Retinal fundus photograph. 2048 by 1536 pixels.
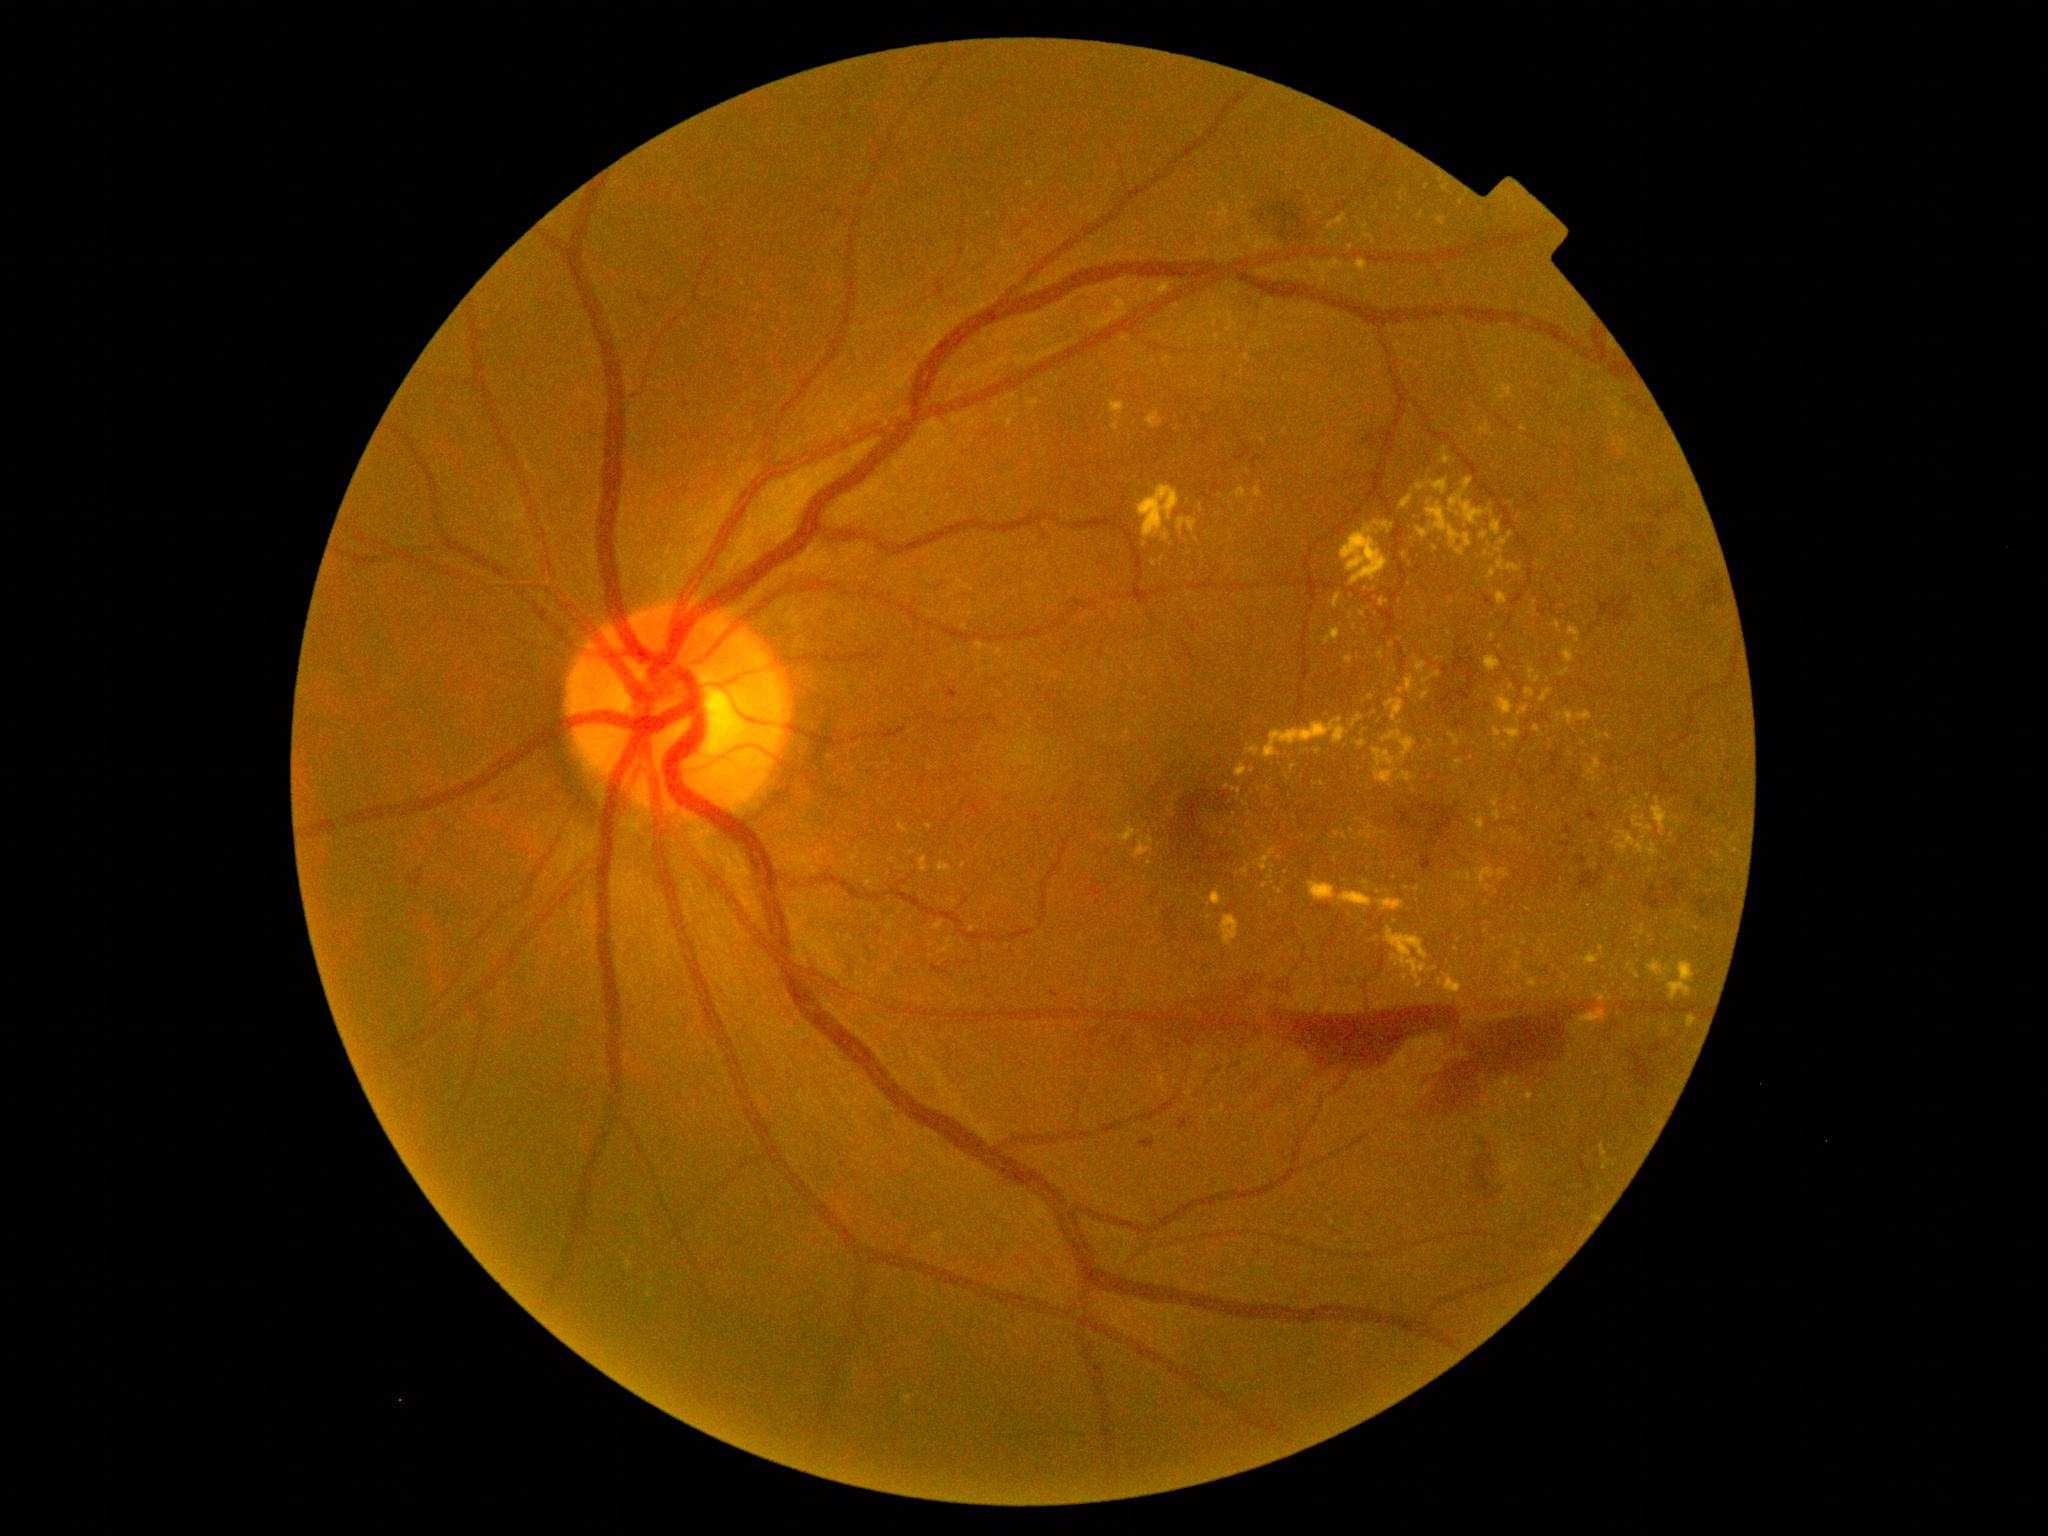
partial: true
dr_grade: 4
lesions:
  ex:
    - rect(1503, 385, 1512, 397)
    - rect(1325, 629, 1341, 644)
    - rect(1476, 869, 1496, 886)
    - rect(1456, 760, 1464, 765)
    - rect(1585, 955, 1599, 965)
    - rect(1529, 669, 1536, 679)
    - rect(1648, 843, 1659, 858)
    - rect(1383, 730, 1416, 757)
    - rect(1688, 1017, 1696, 1028)
  ex_small_approx:
    - 1405:978
    - 1149:841
    - 909:1398
    - 1644:840
    - 1461:203
    - 1345:837
    - 1430:503
    - 1512:688
    - 1253:771